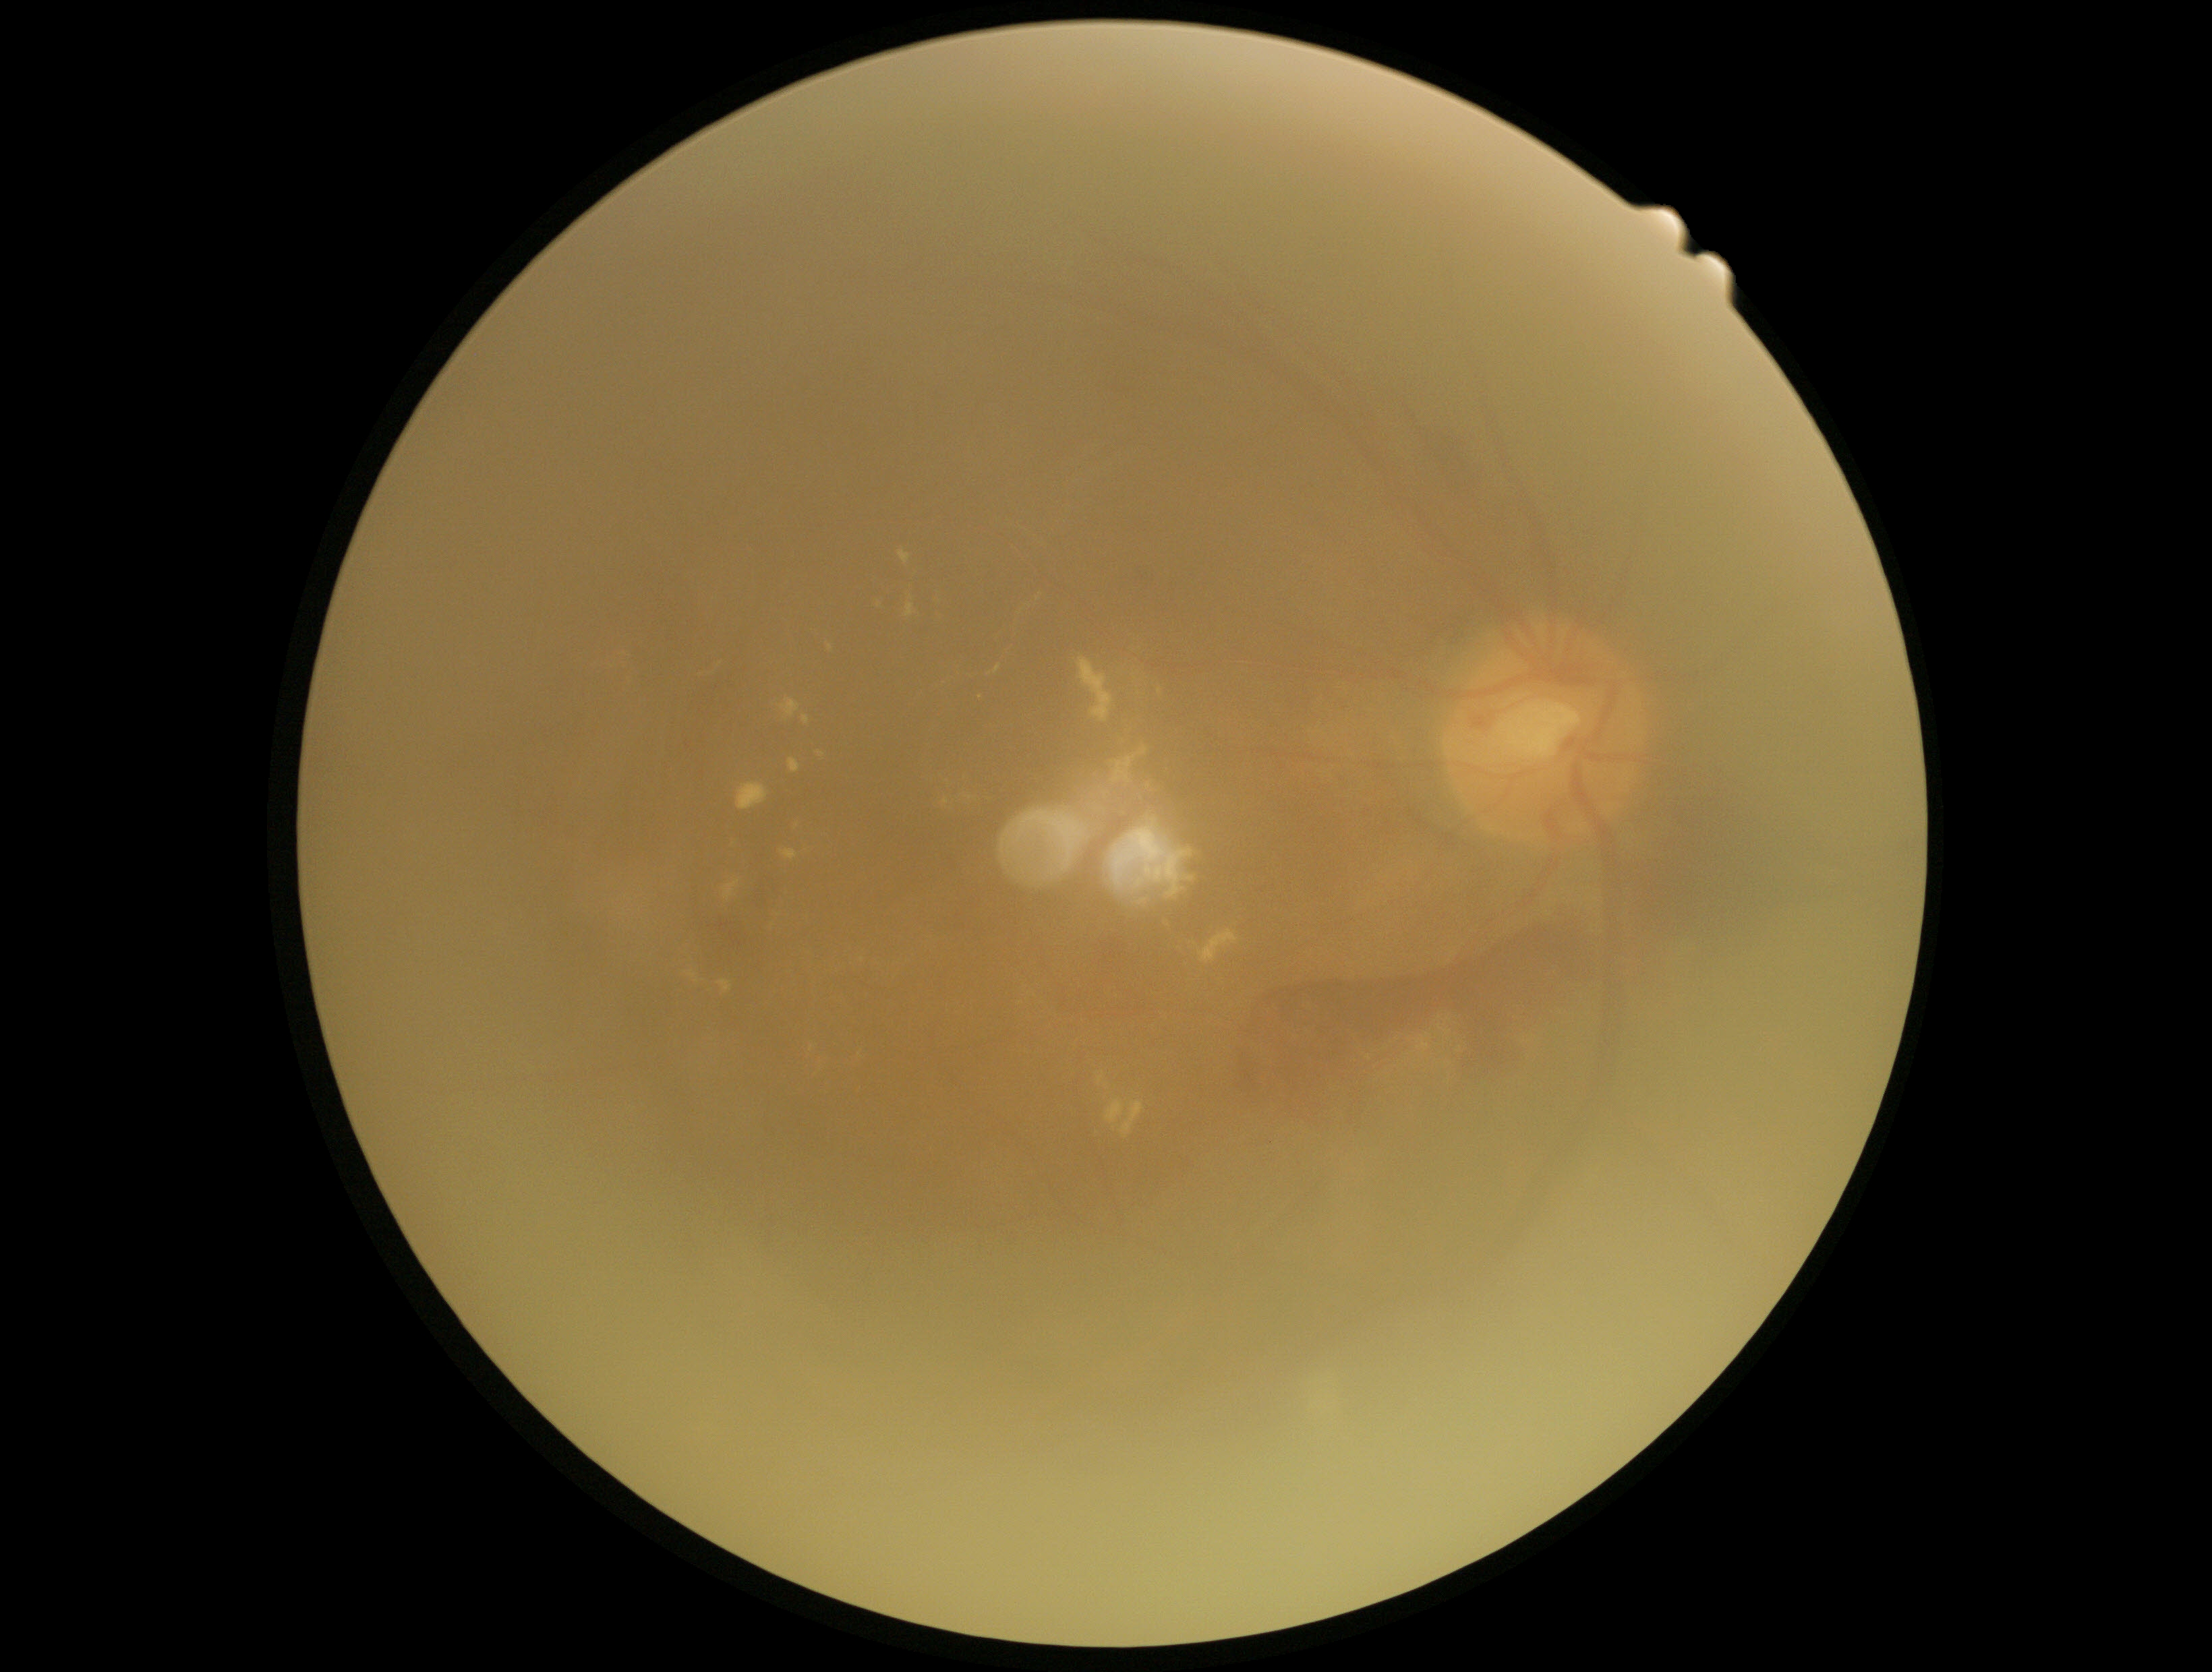

* retinopathy grade: 4